2352 by 1568 pixels; 45° field of view; fundus photo:
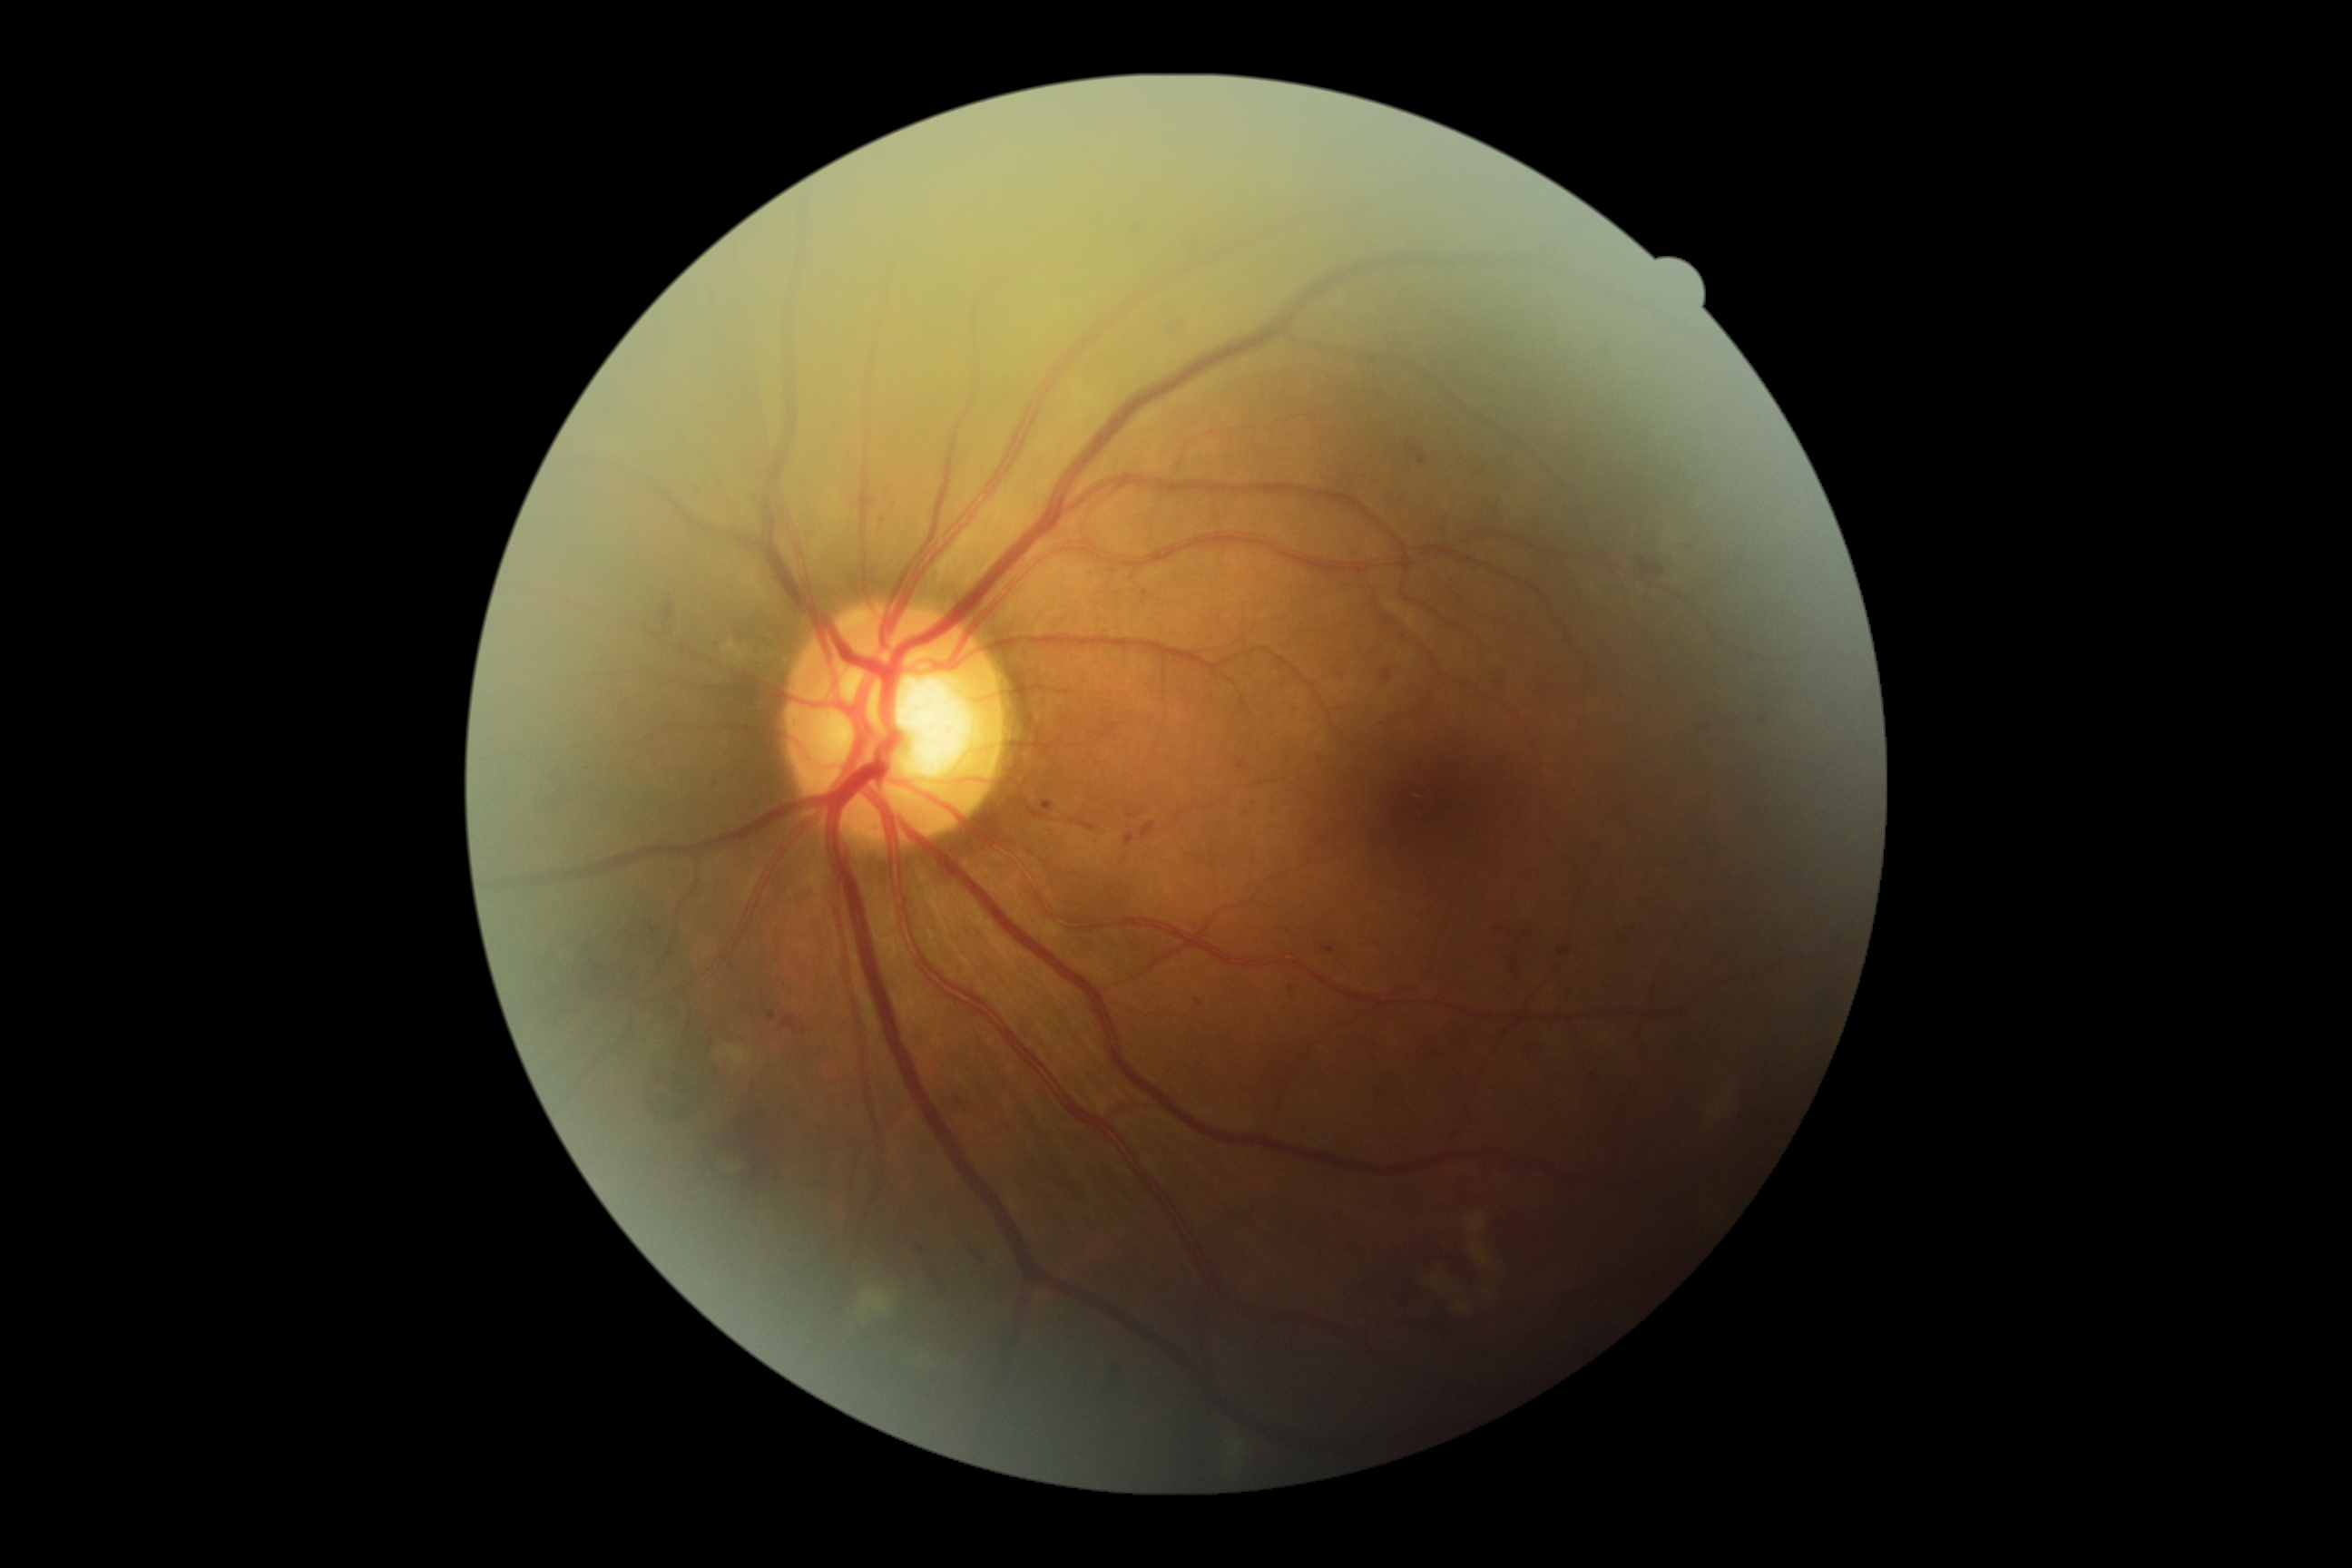
Diabetic retinopathy severity: grade 2.